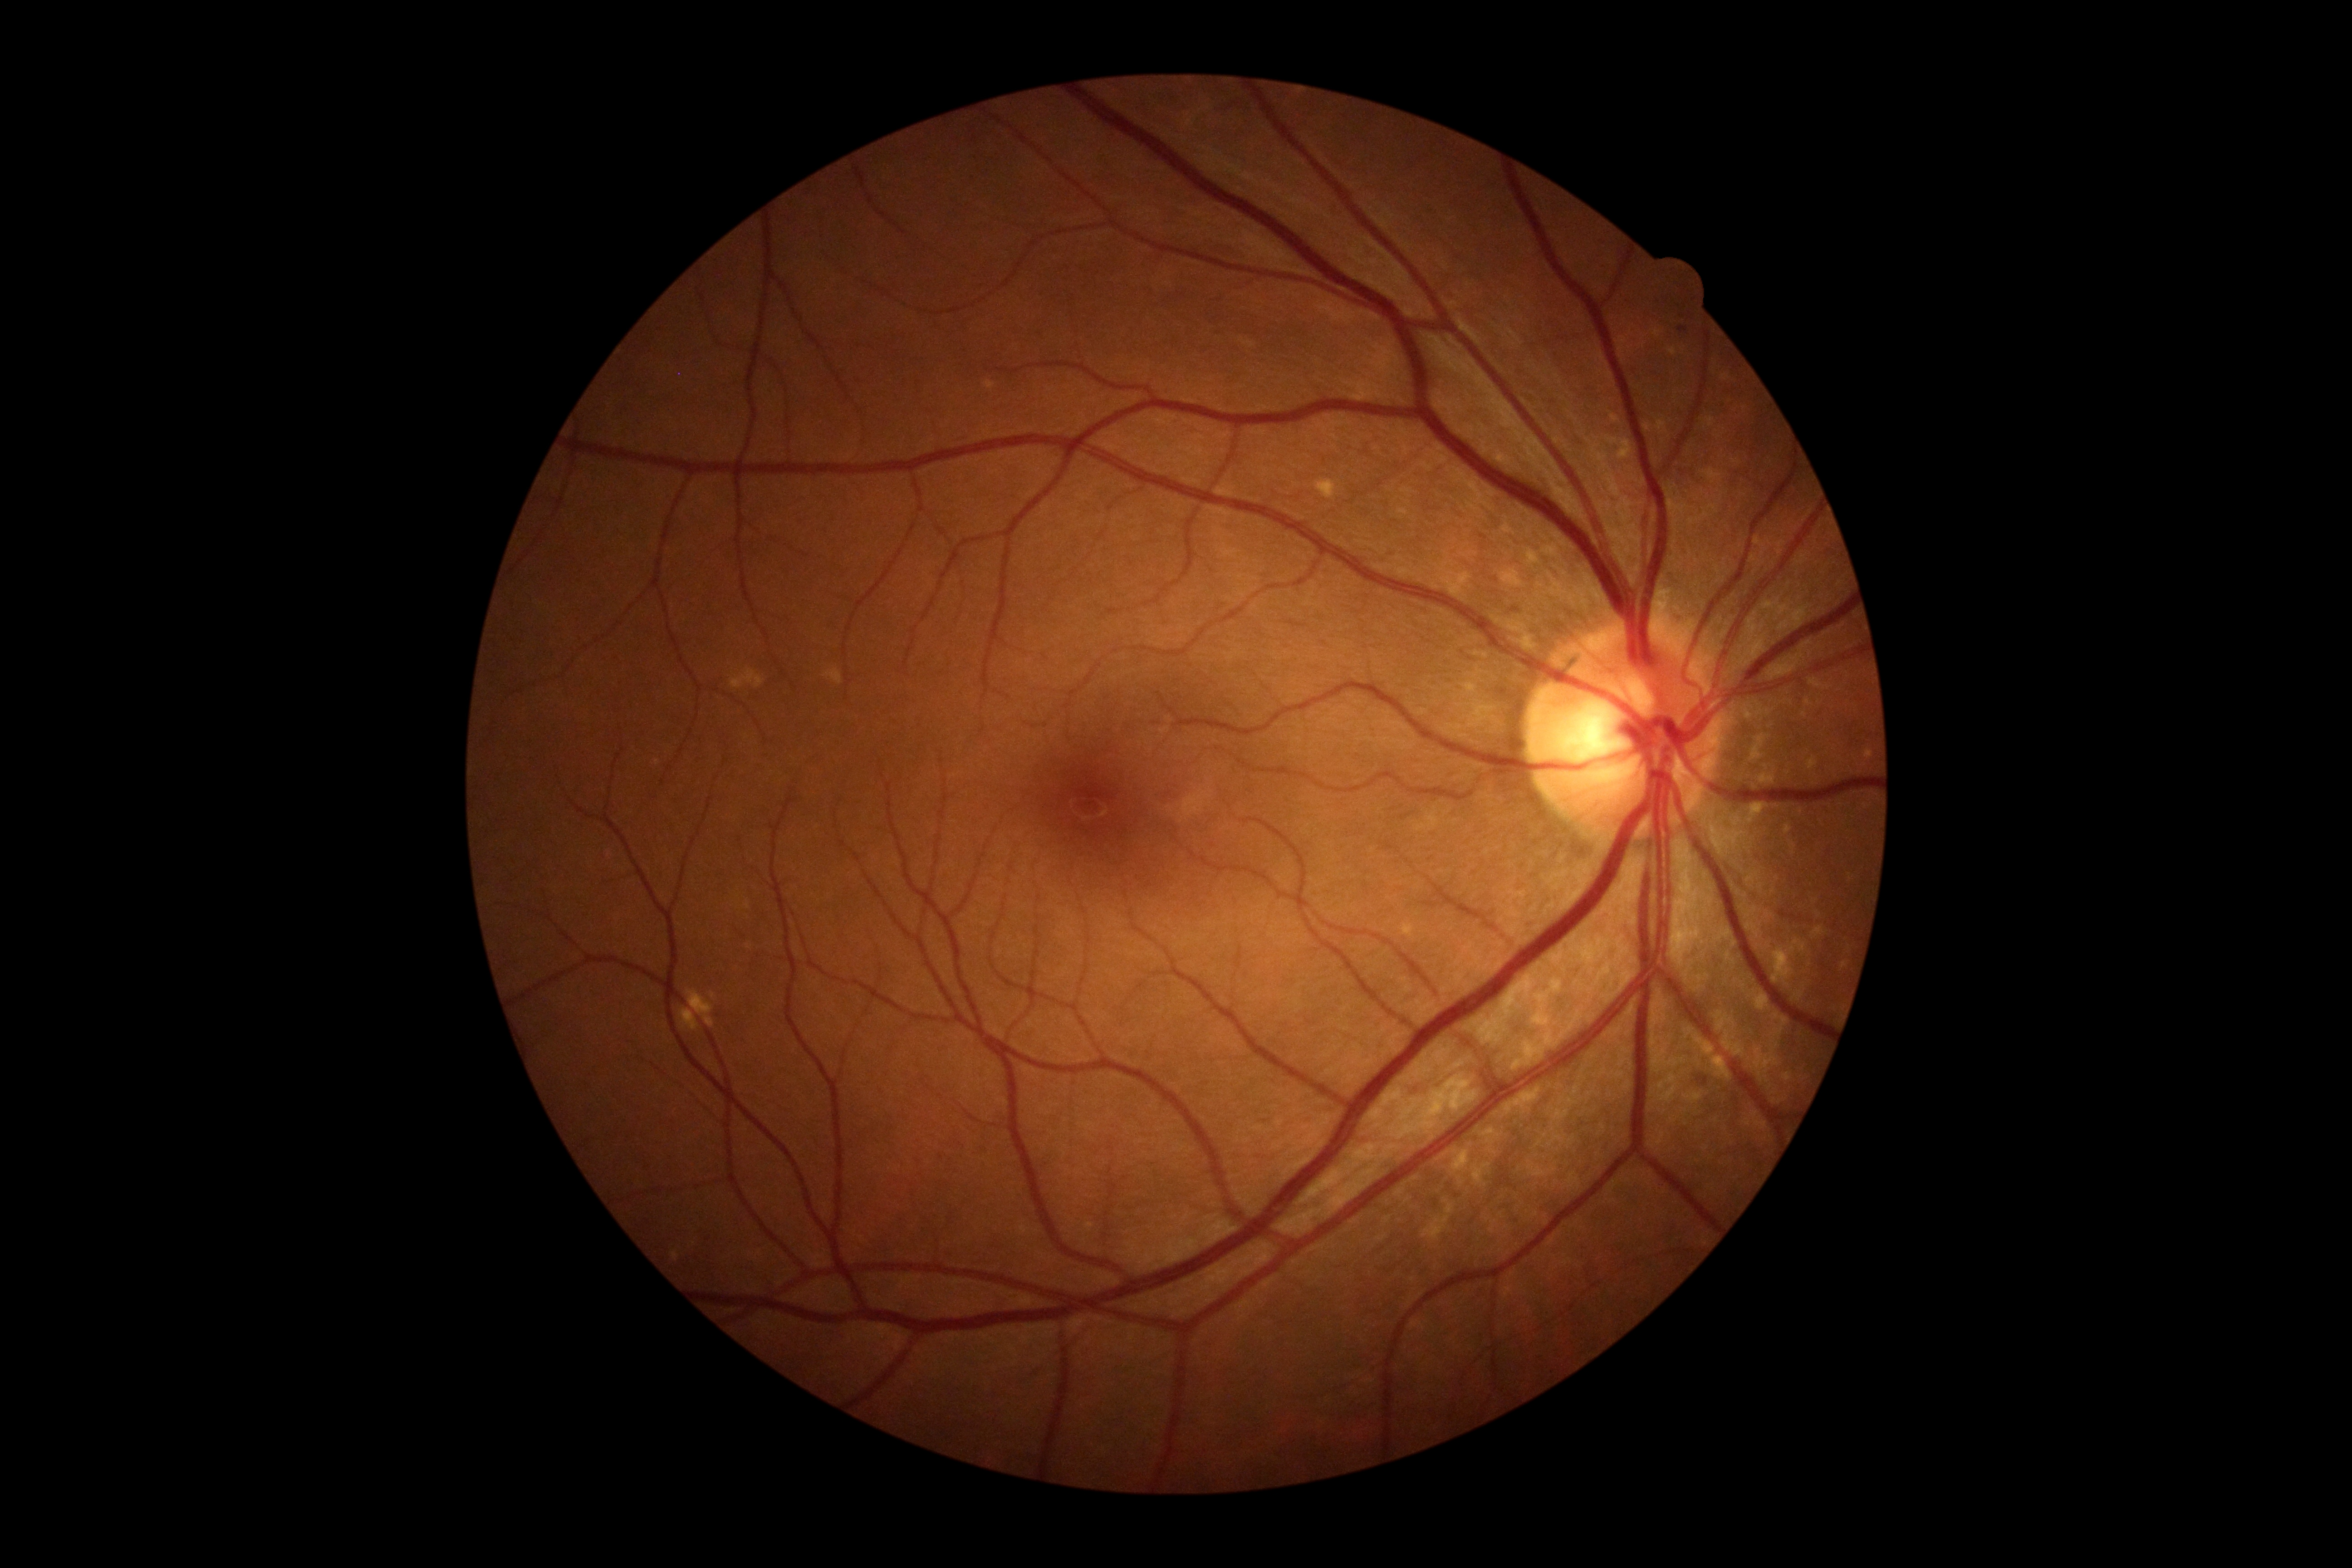
Diabetic retinopathy (DR) is 0/4. No signs of diabetic retinopathy.